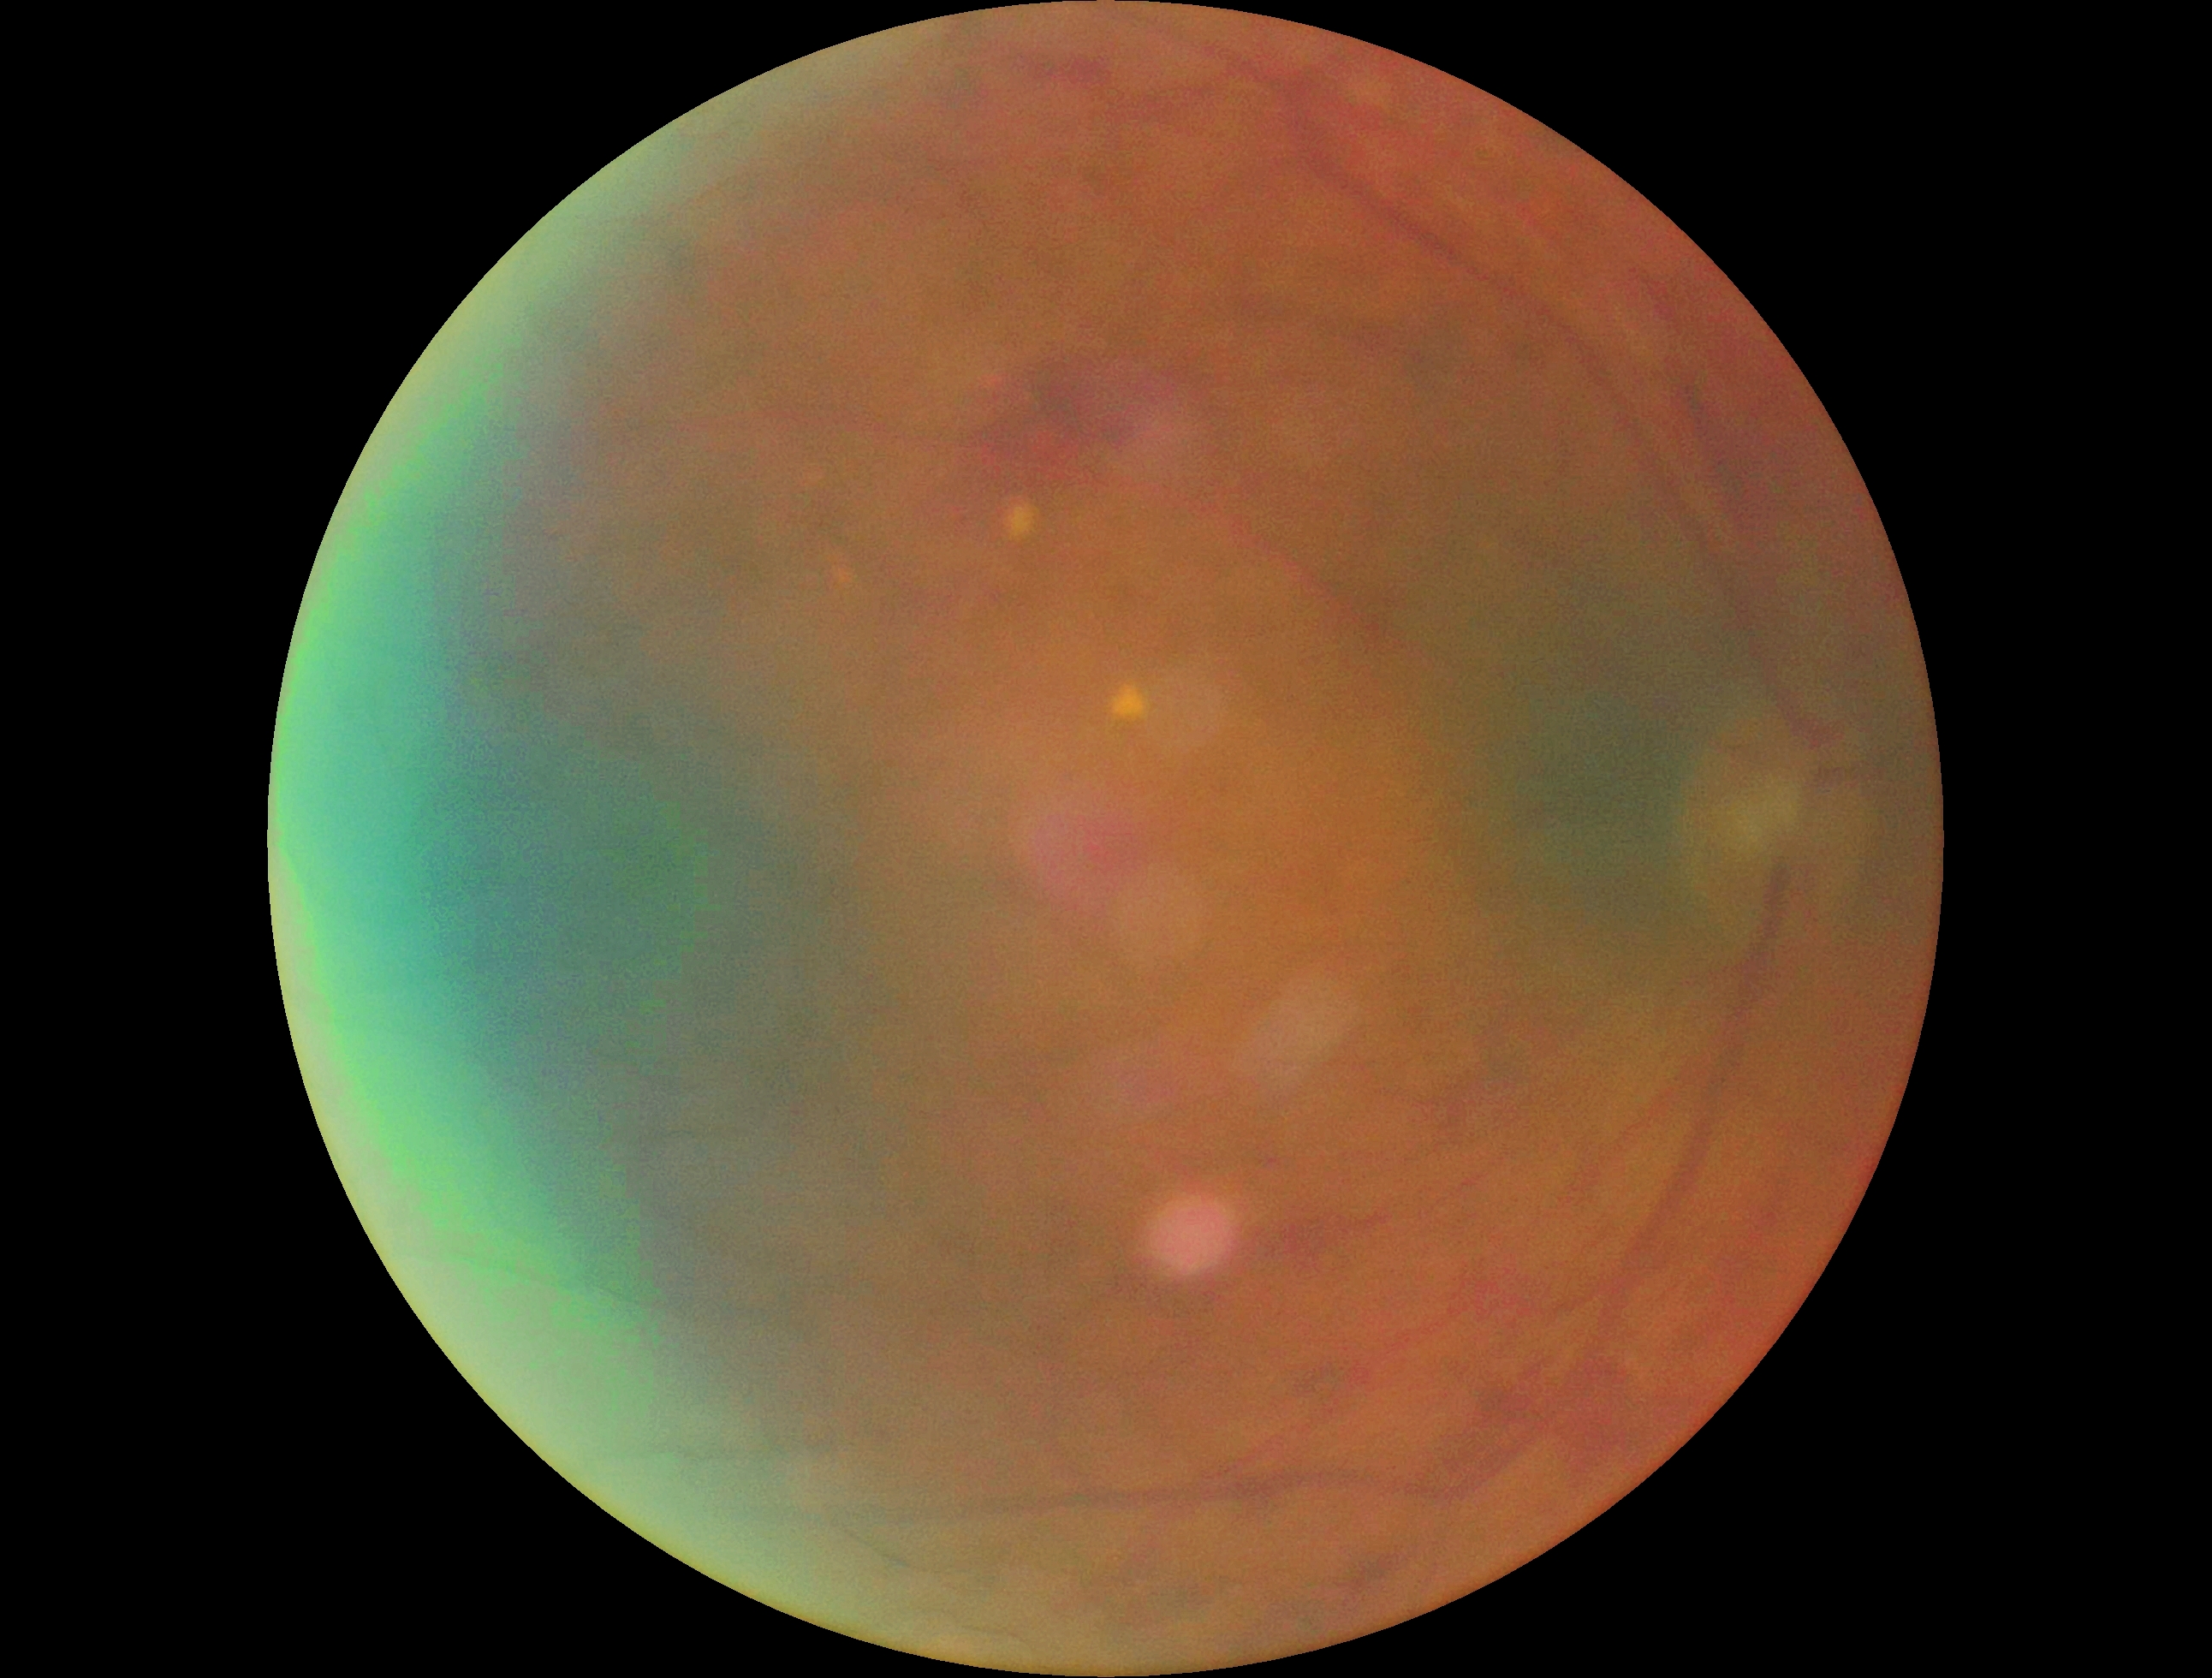

Diabetic retinopathy grade: 2/4 — more than just microaneurysms but less than severe NPDR.